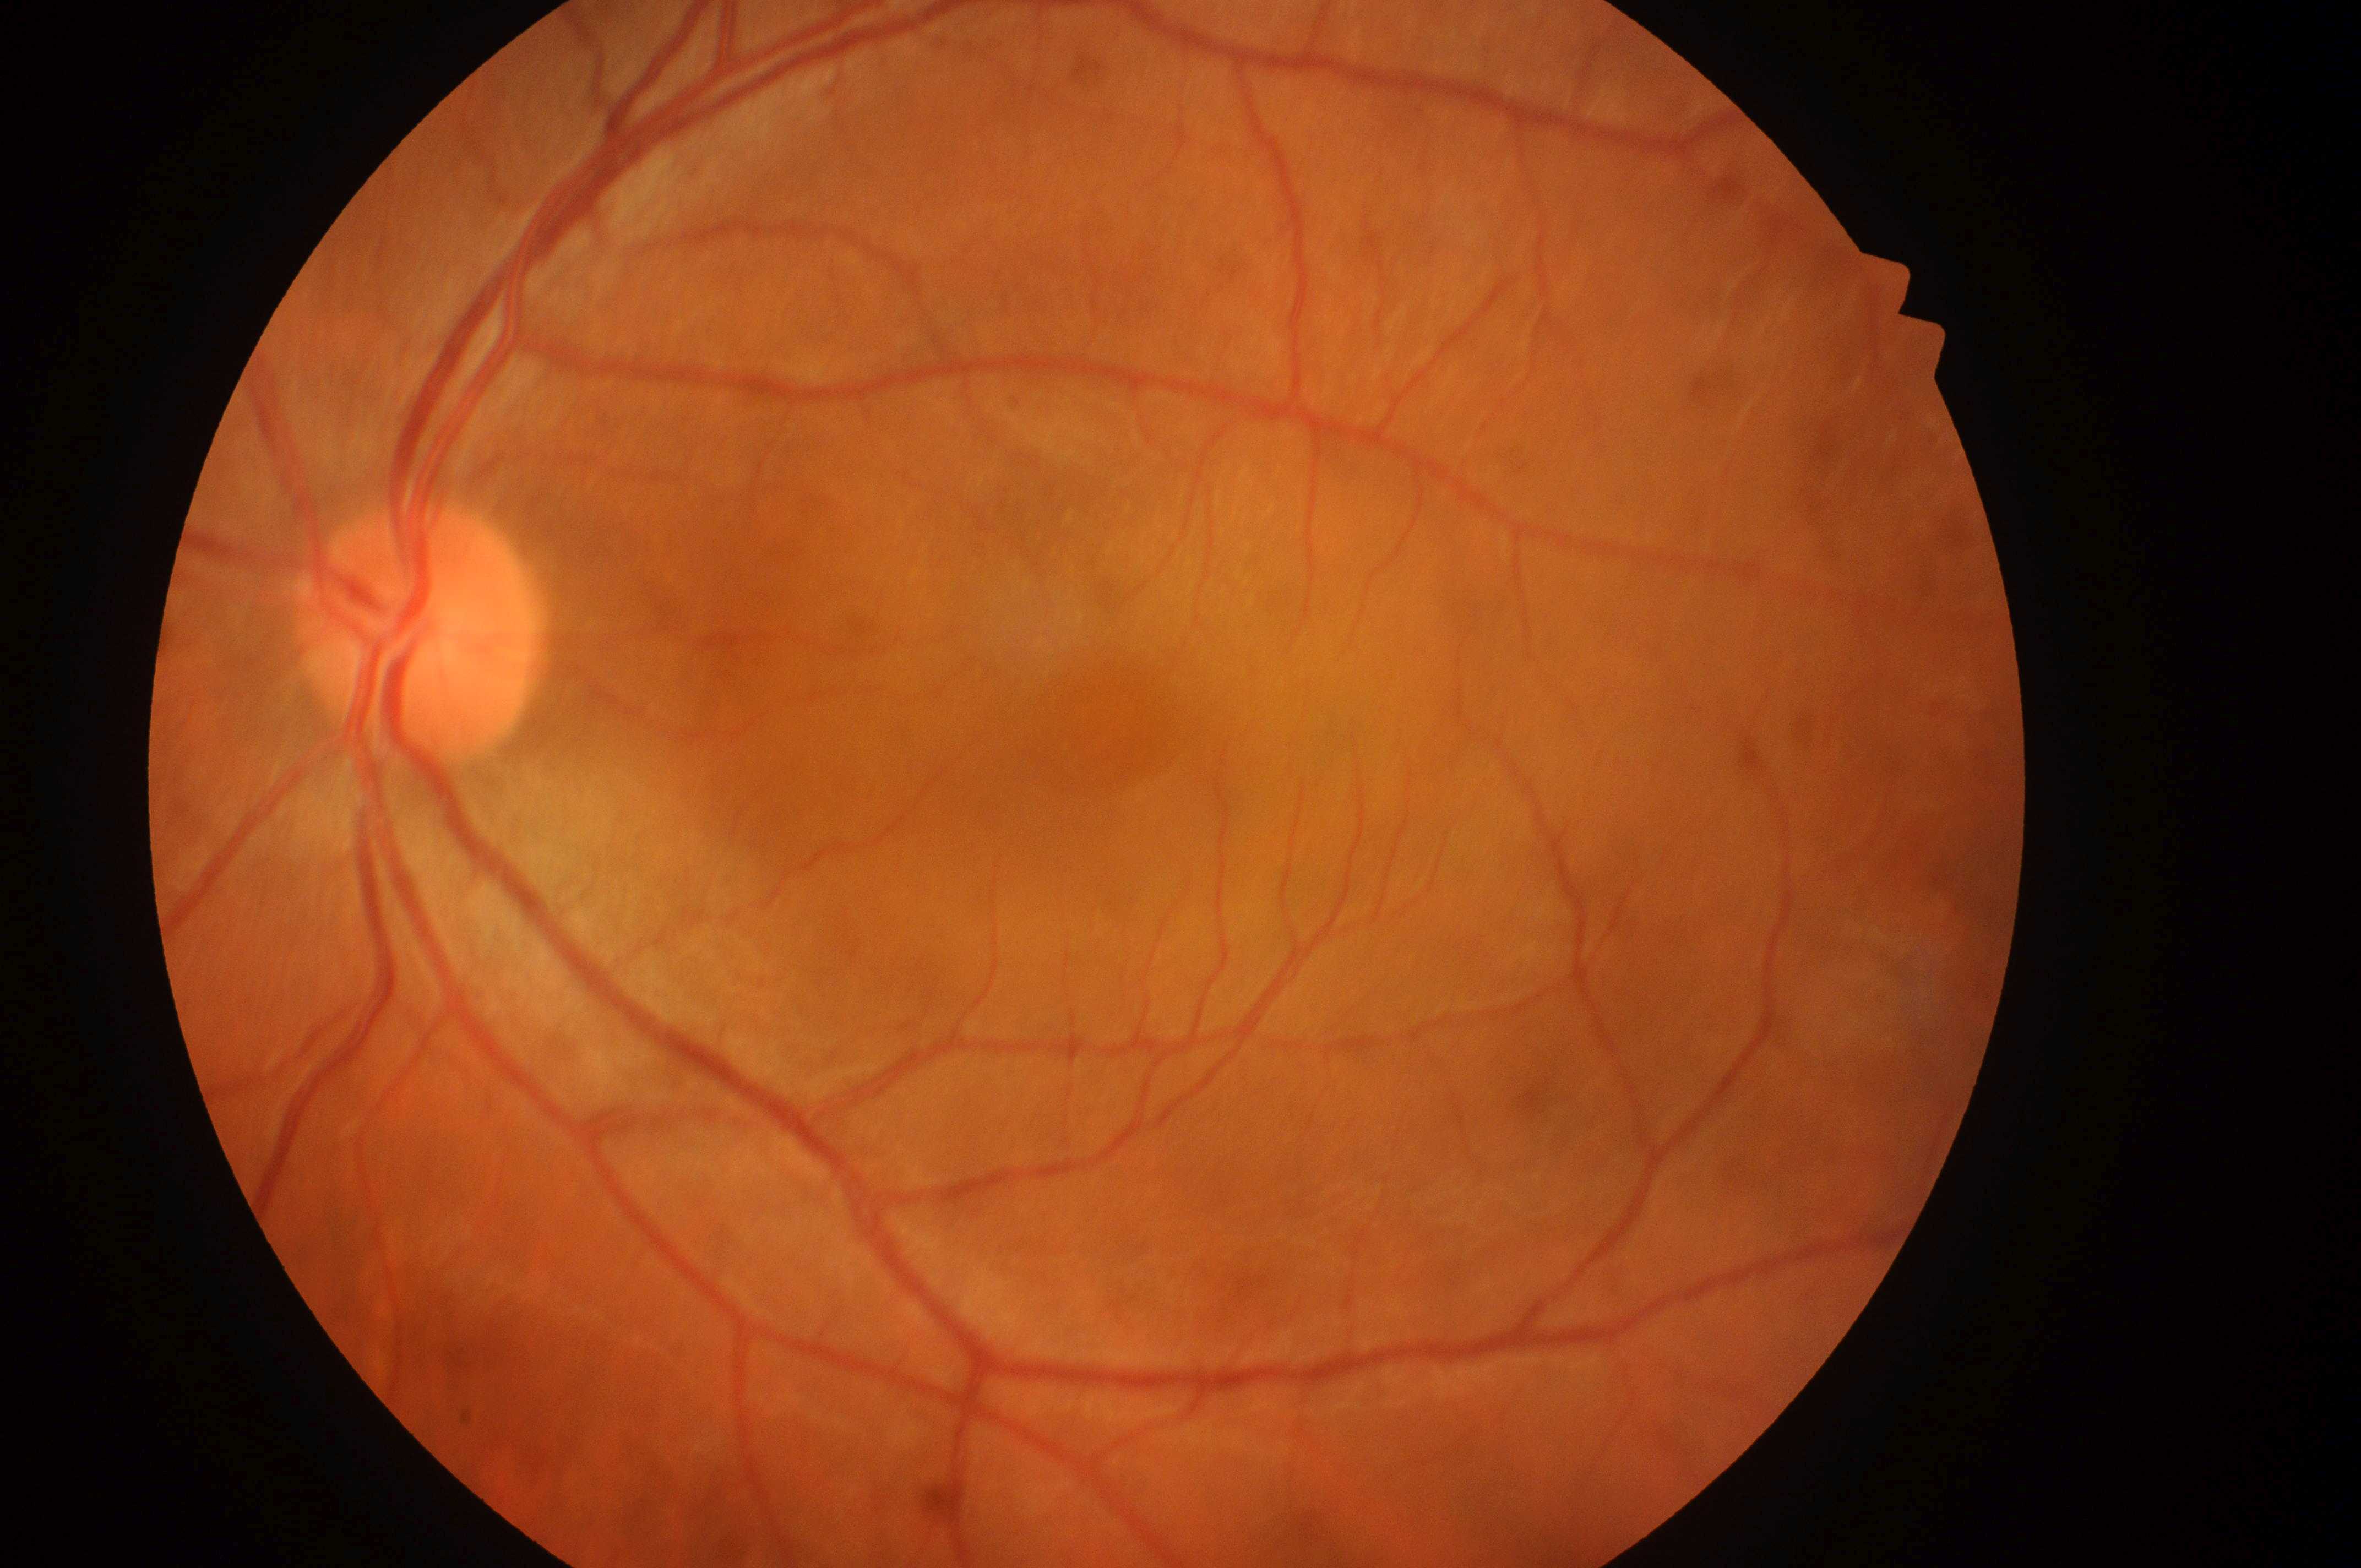

DR stage is grade 0. The ONH is at [418, 639]. No apparent diabetic retinopathy or macular edema. DME is grade 0. The image shows the left eye. Fovea located at [1109, 723].